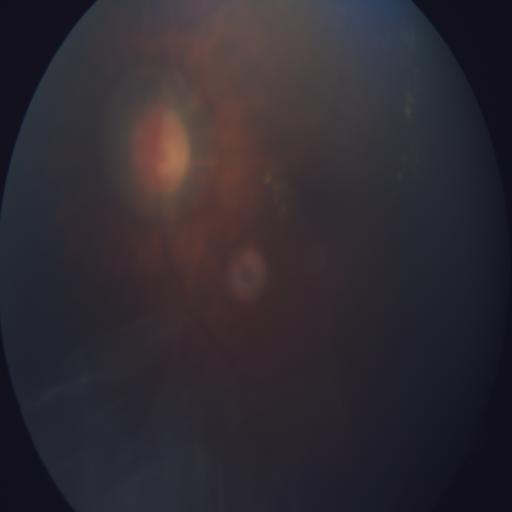 Diagnoses: media haze.